Nonmydriatic, 45 degree fundus photograph
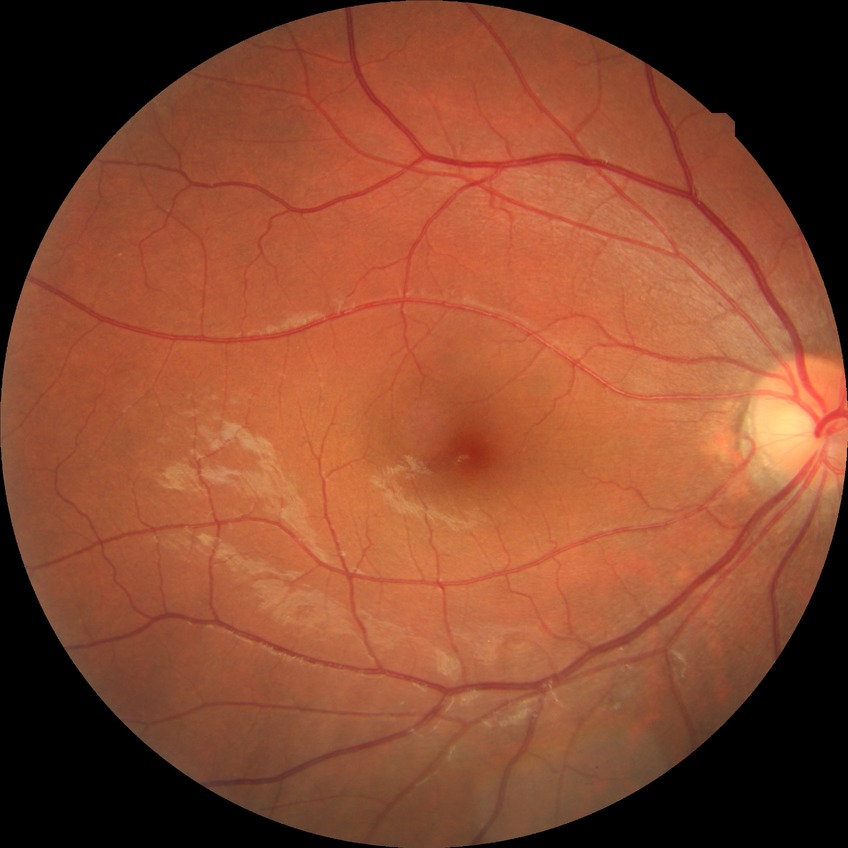

diabetic retinopathy (DR): no diabetic retinopathy (NDR)